45° field of view:
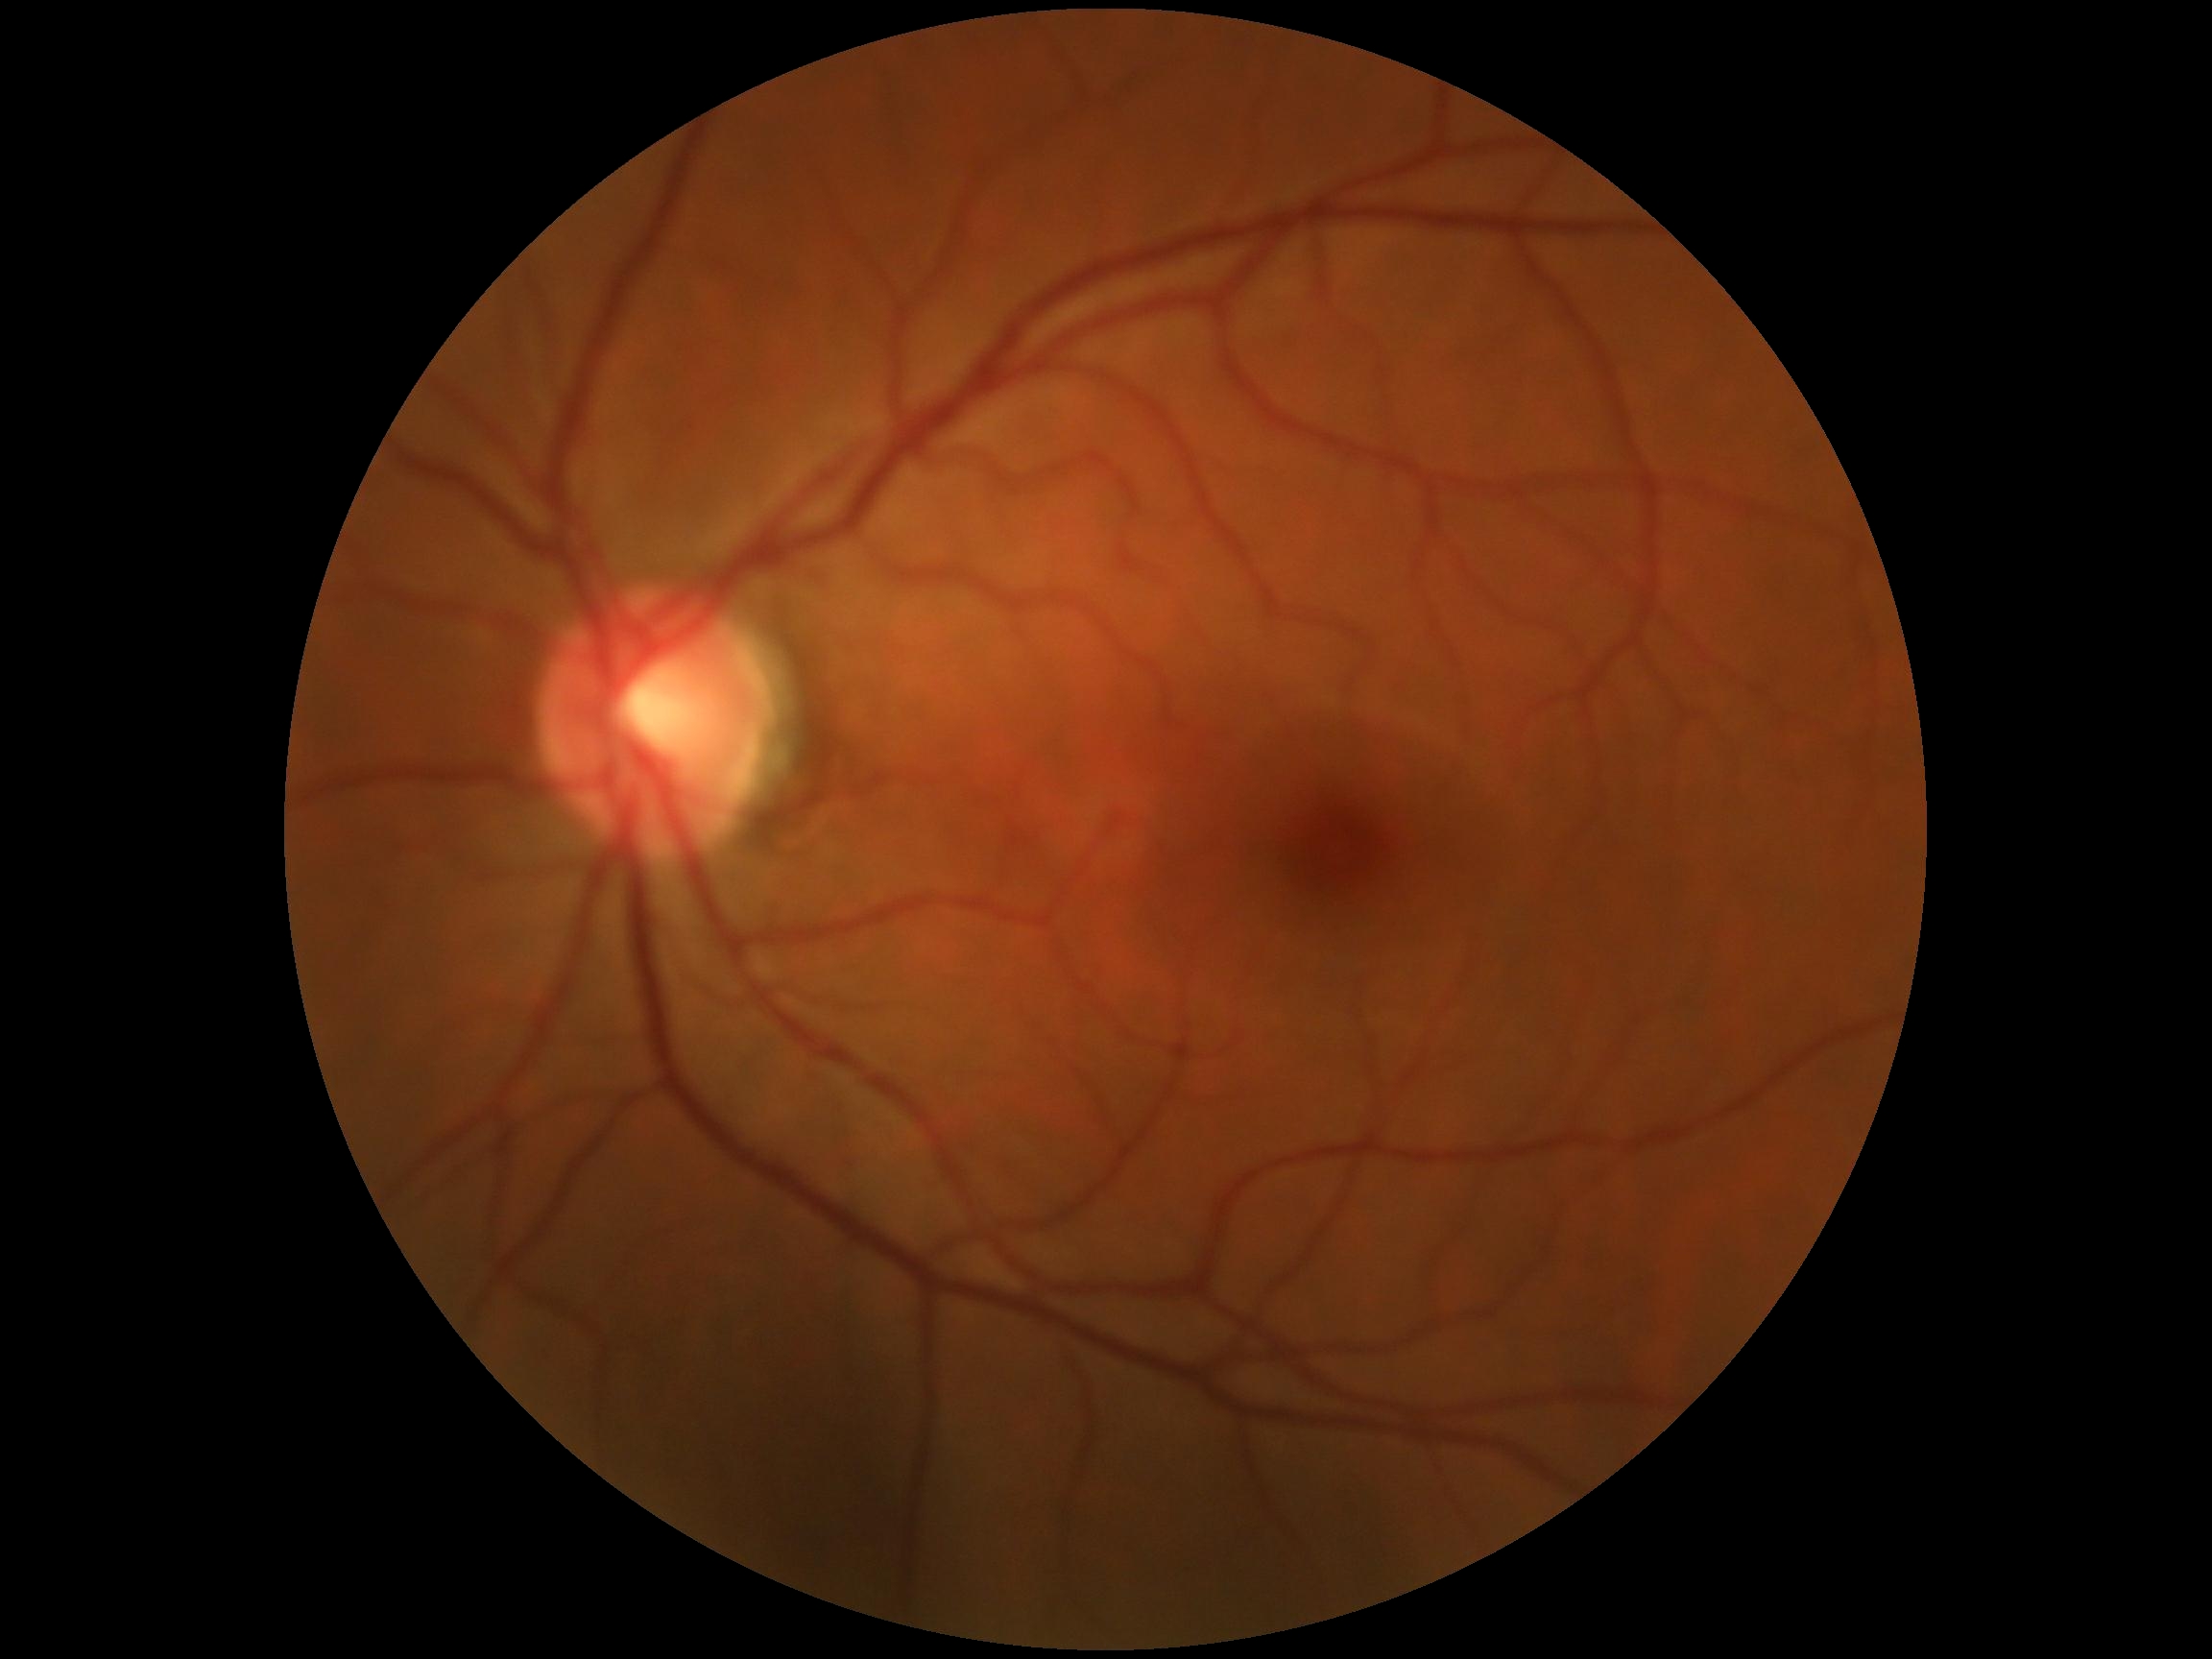

DR: grade 0 (no apparent retinopathy).